848x848.
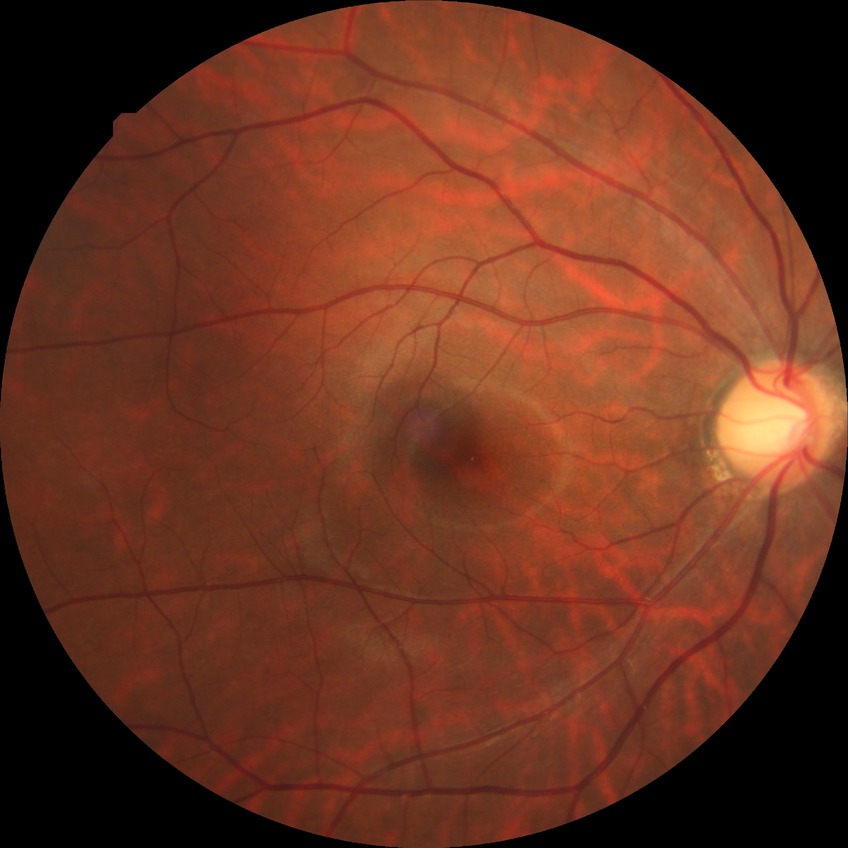

Diabetic retinopathy severity: no diabetic retinopathy.